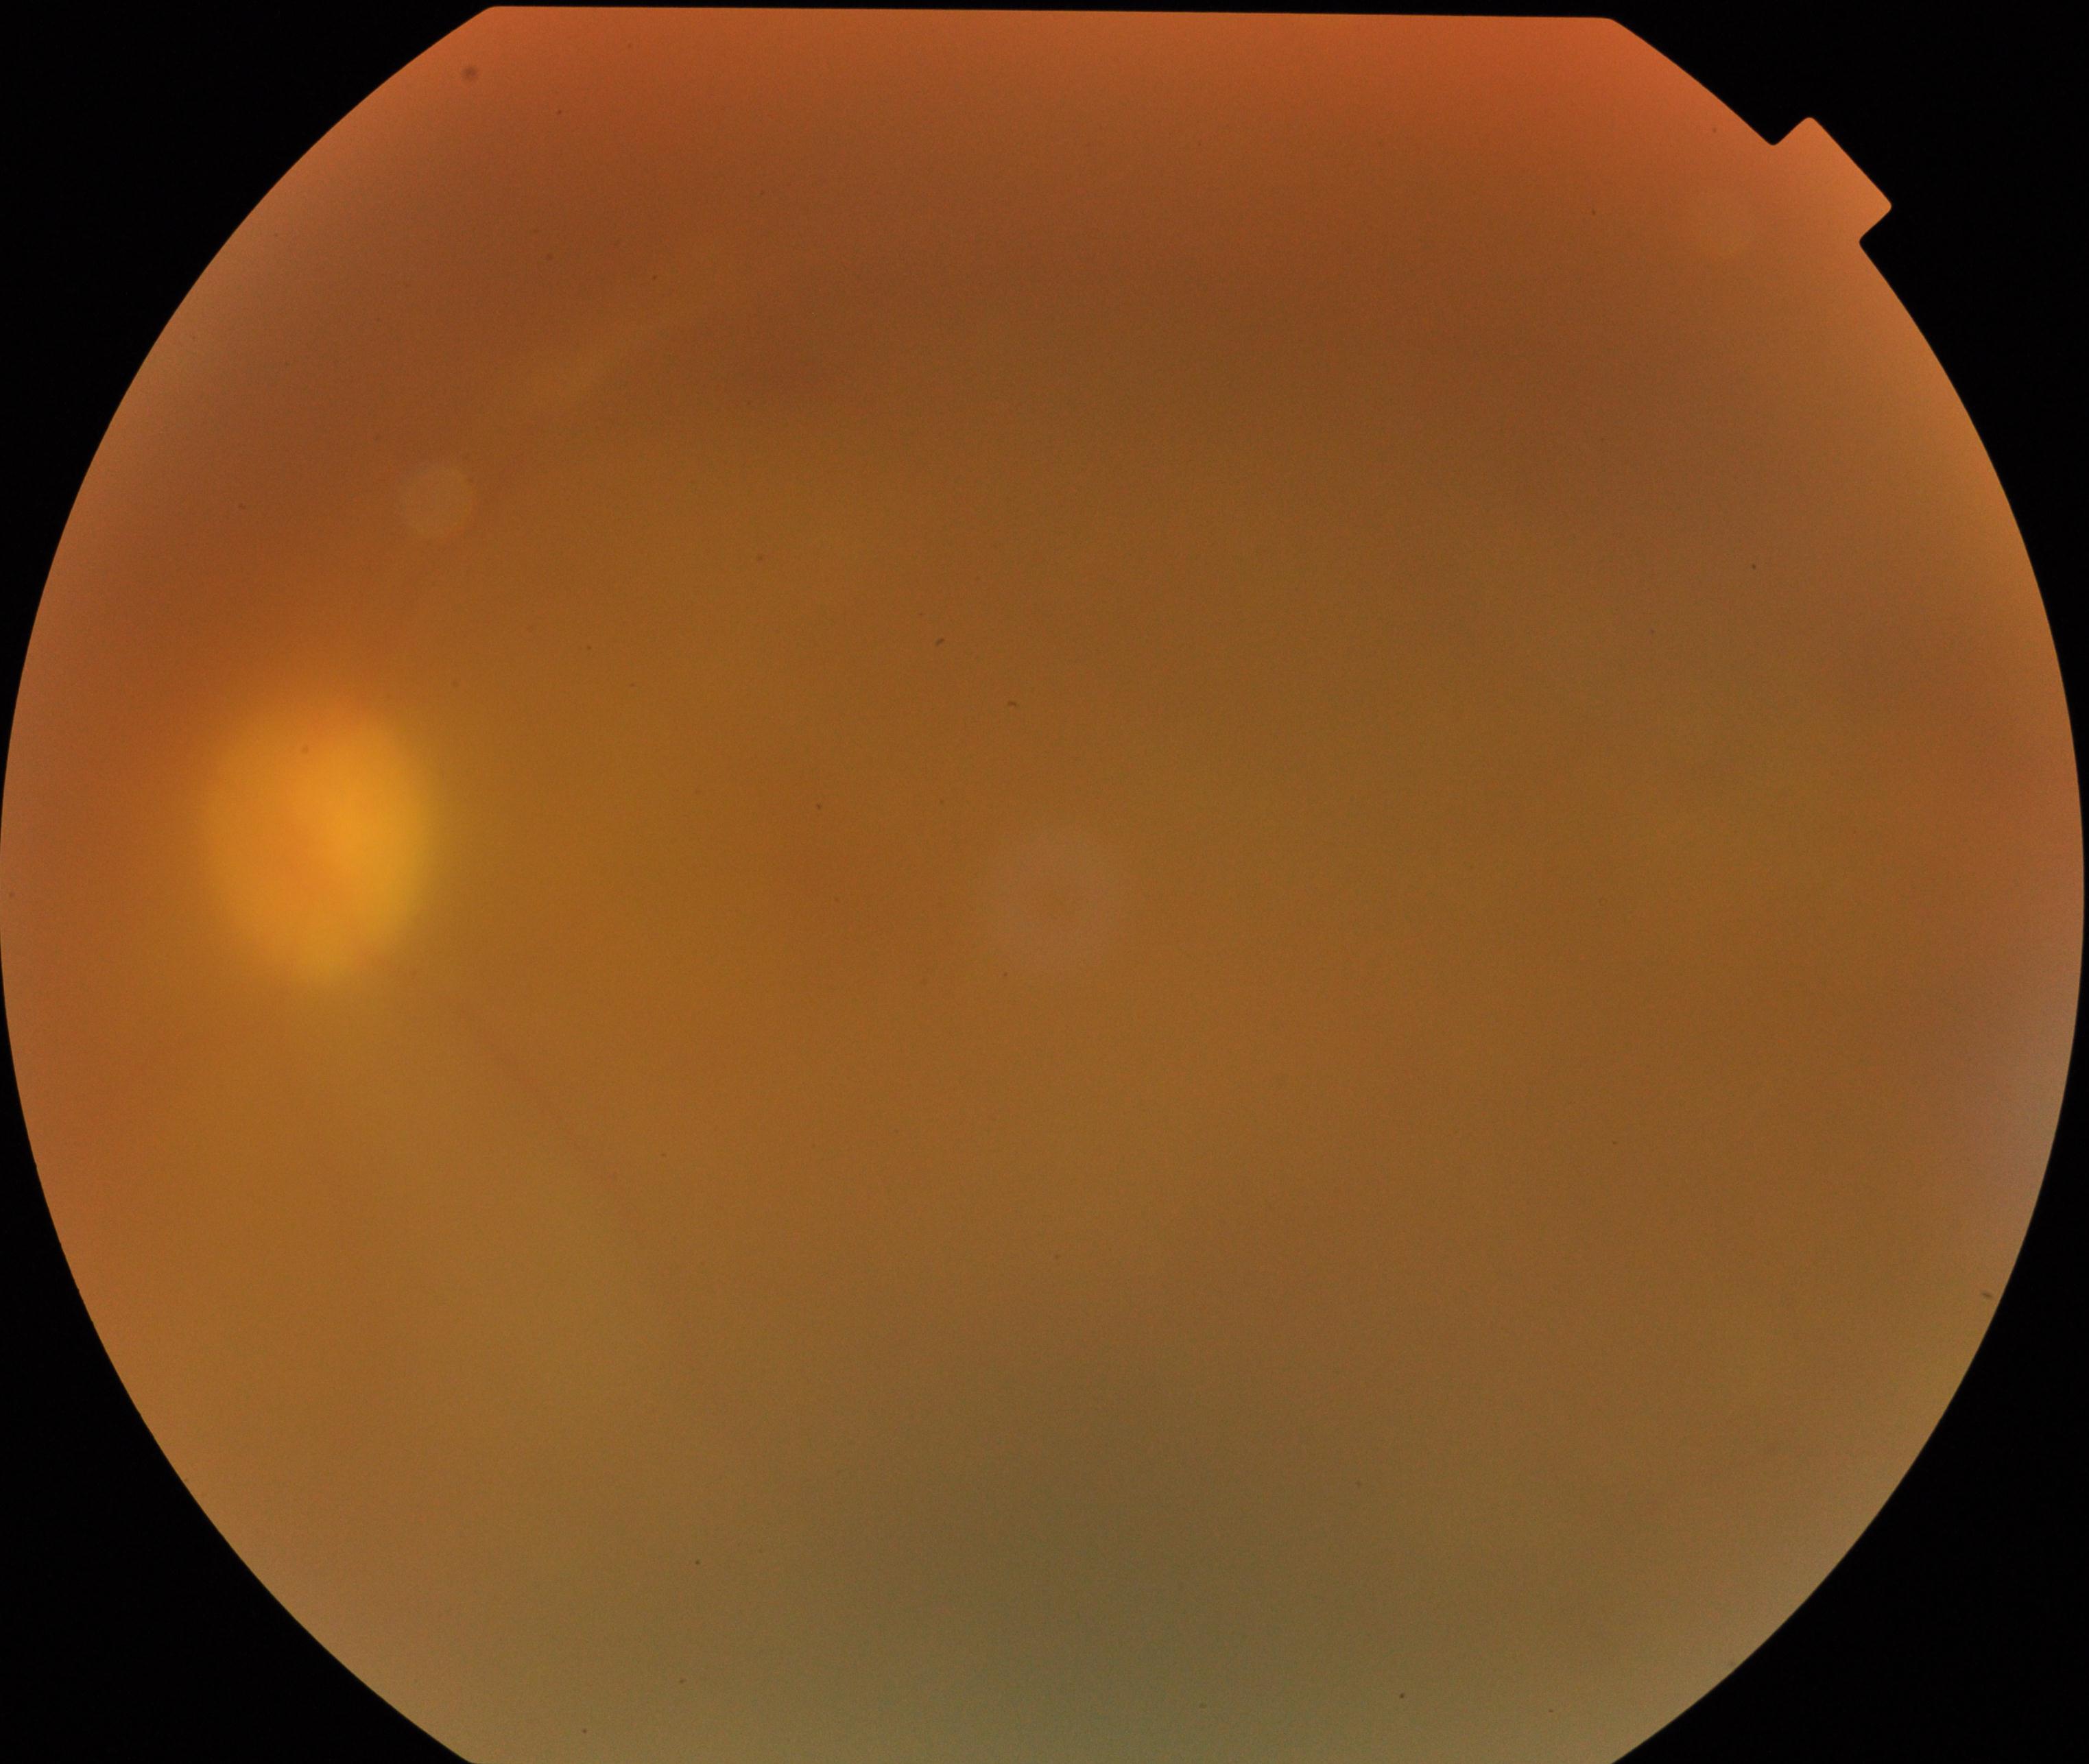
Image quality: significantly degraded.
Proliferative retinopathy: not identified.